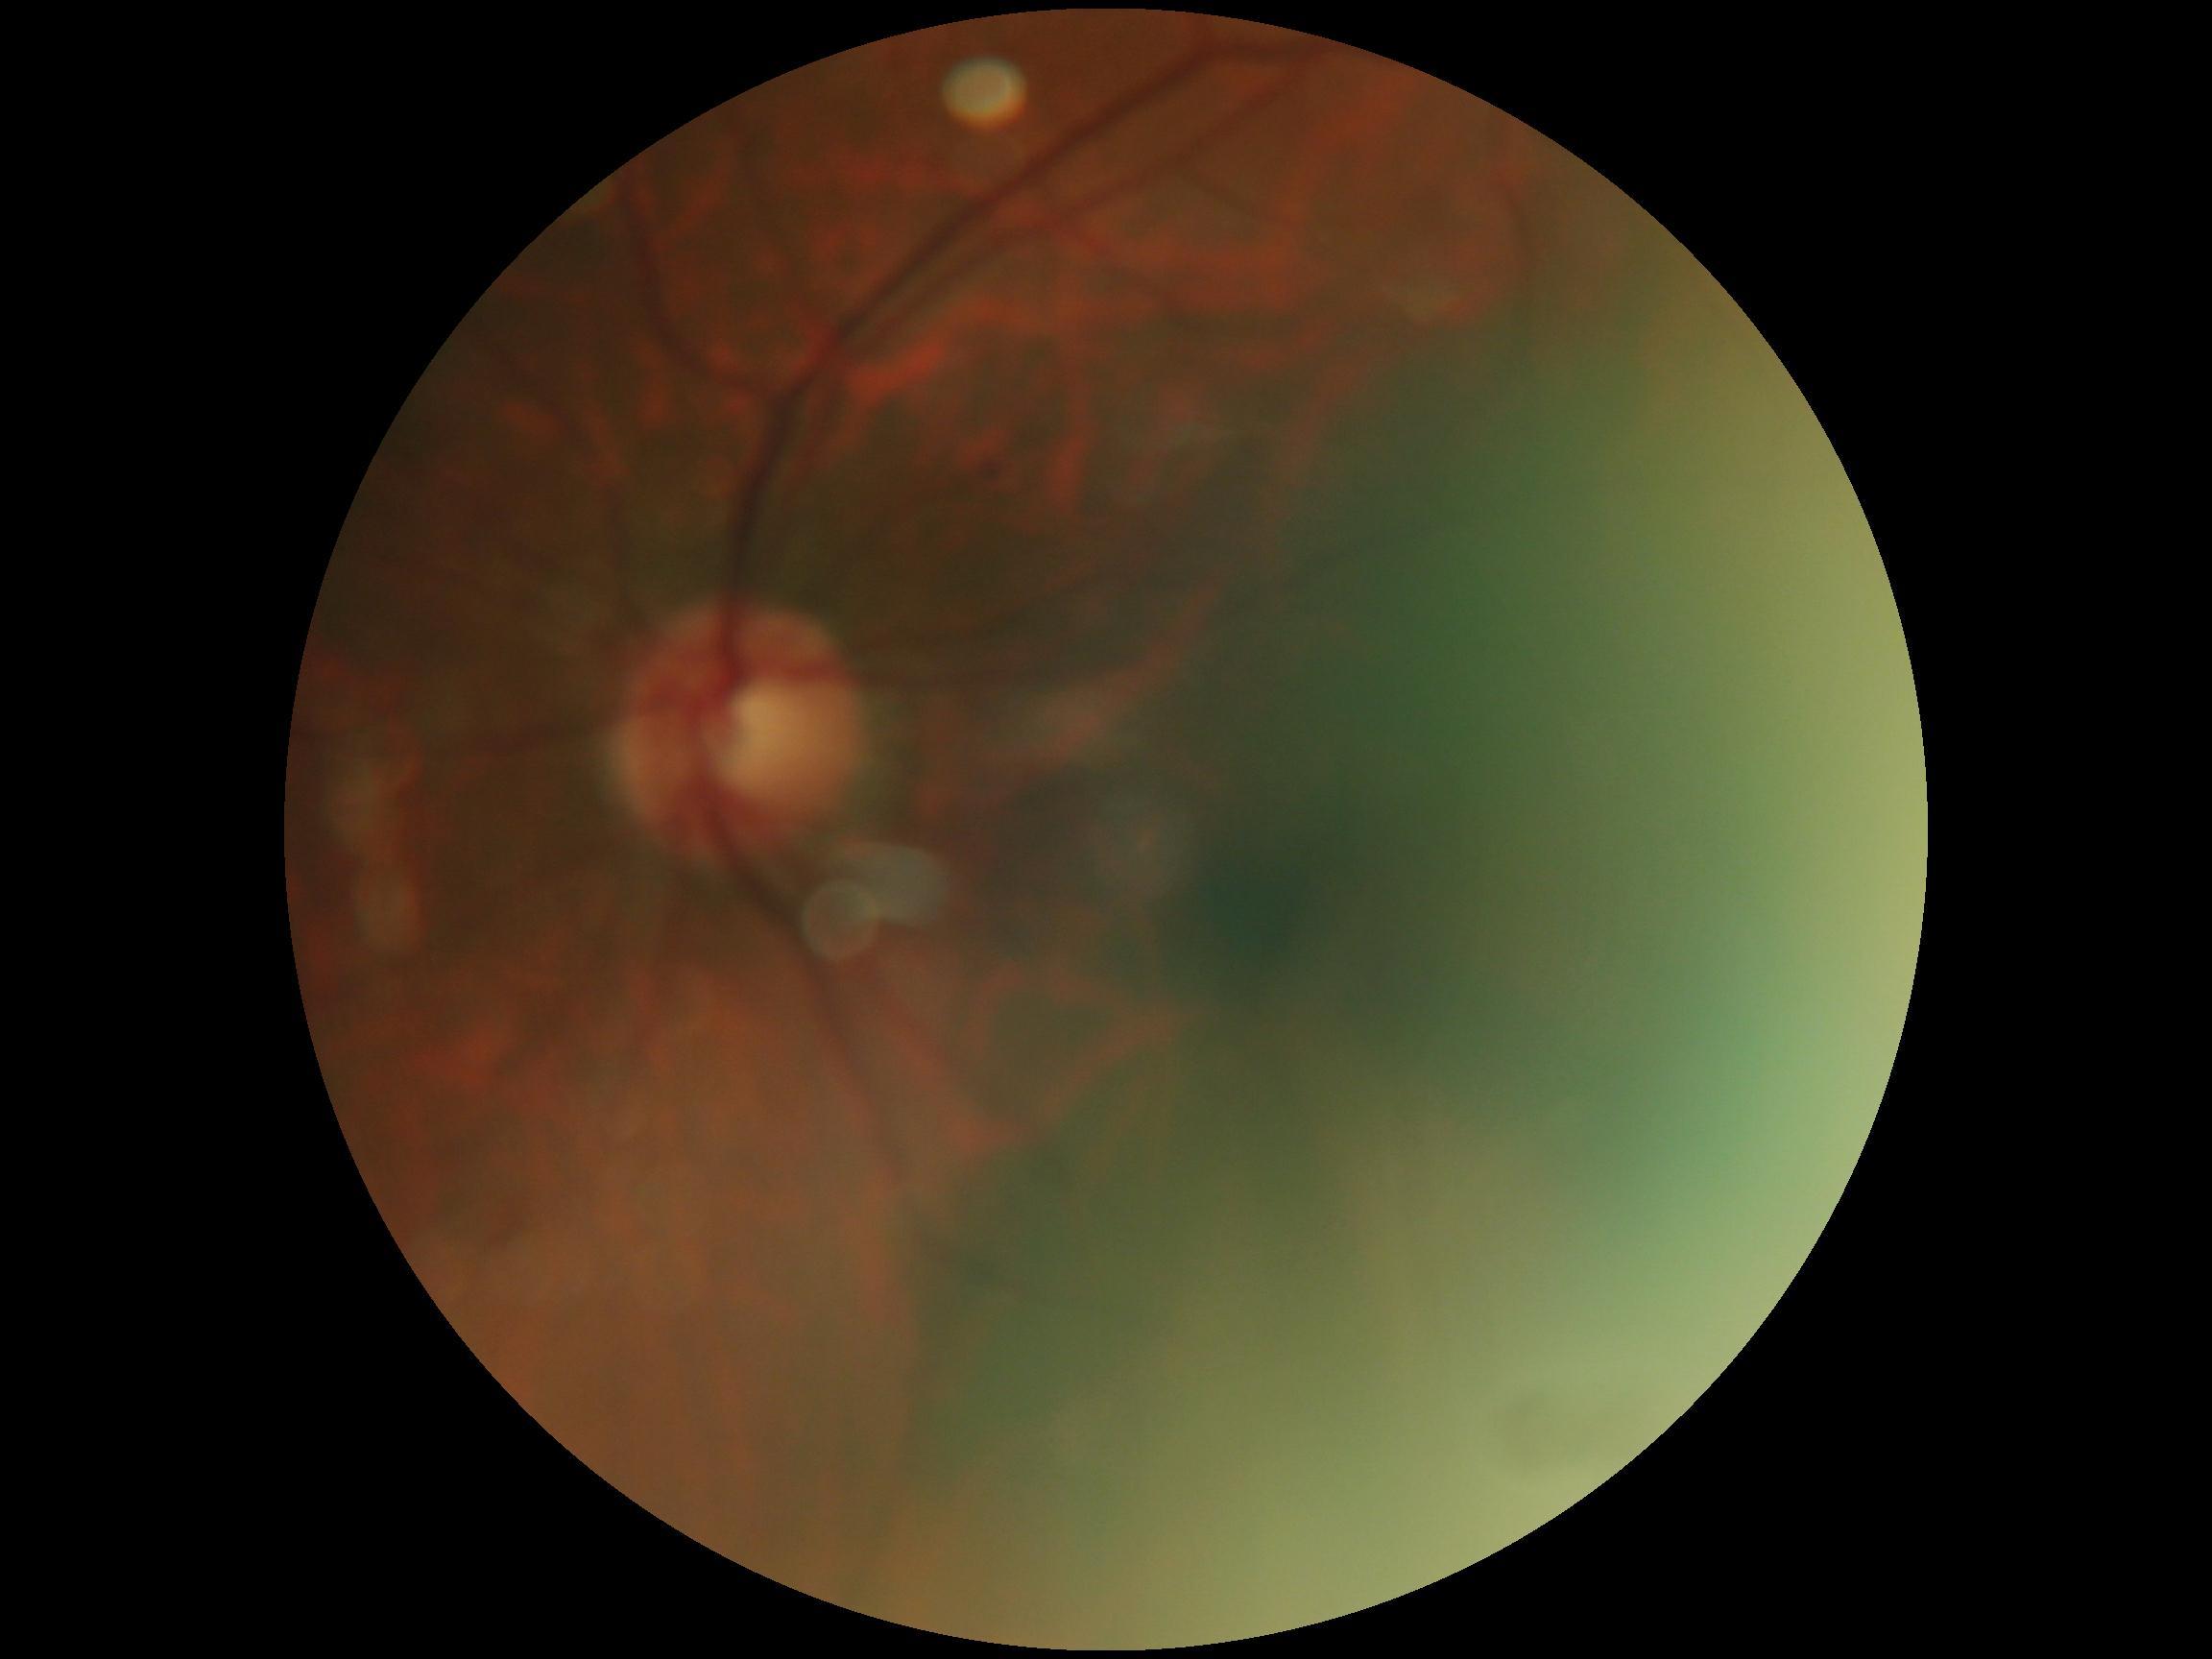

Diabetic retinopathy (DR): 0/4.